45 degree fundus photograph · without pupil dilation · retinal fundus photograph: 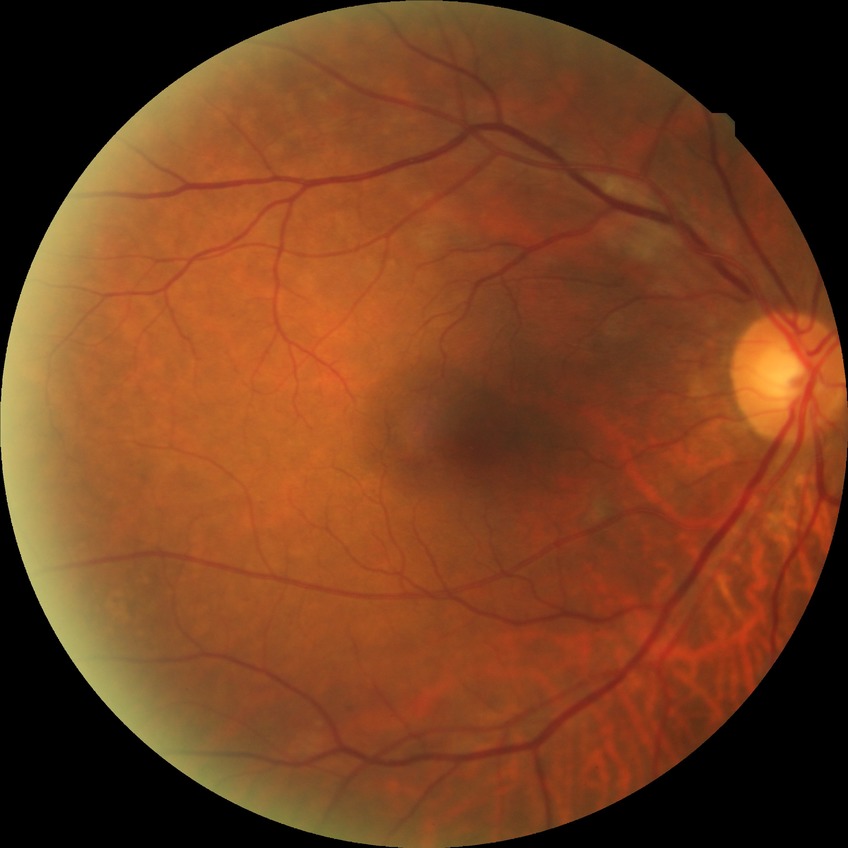
Diabetic retinopathy (DR): pre-proliferative diabetic retinopathy (PPDR).